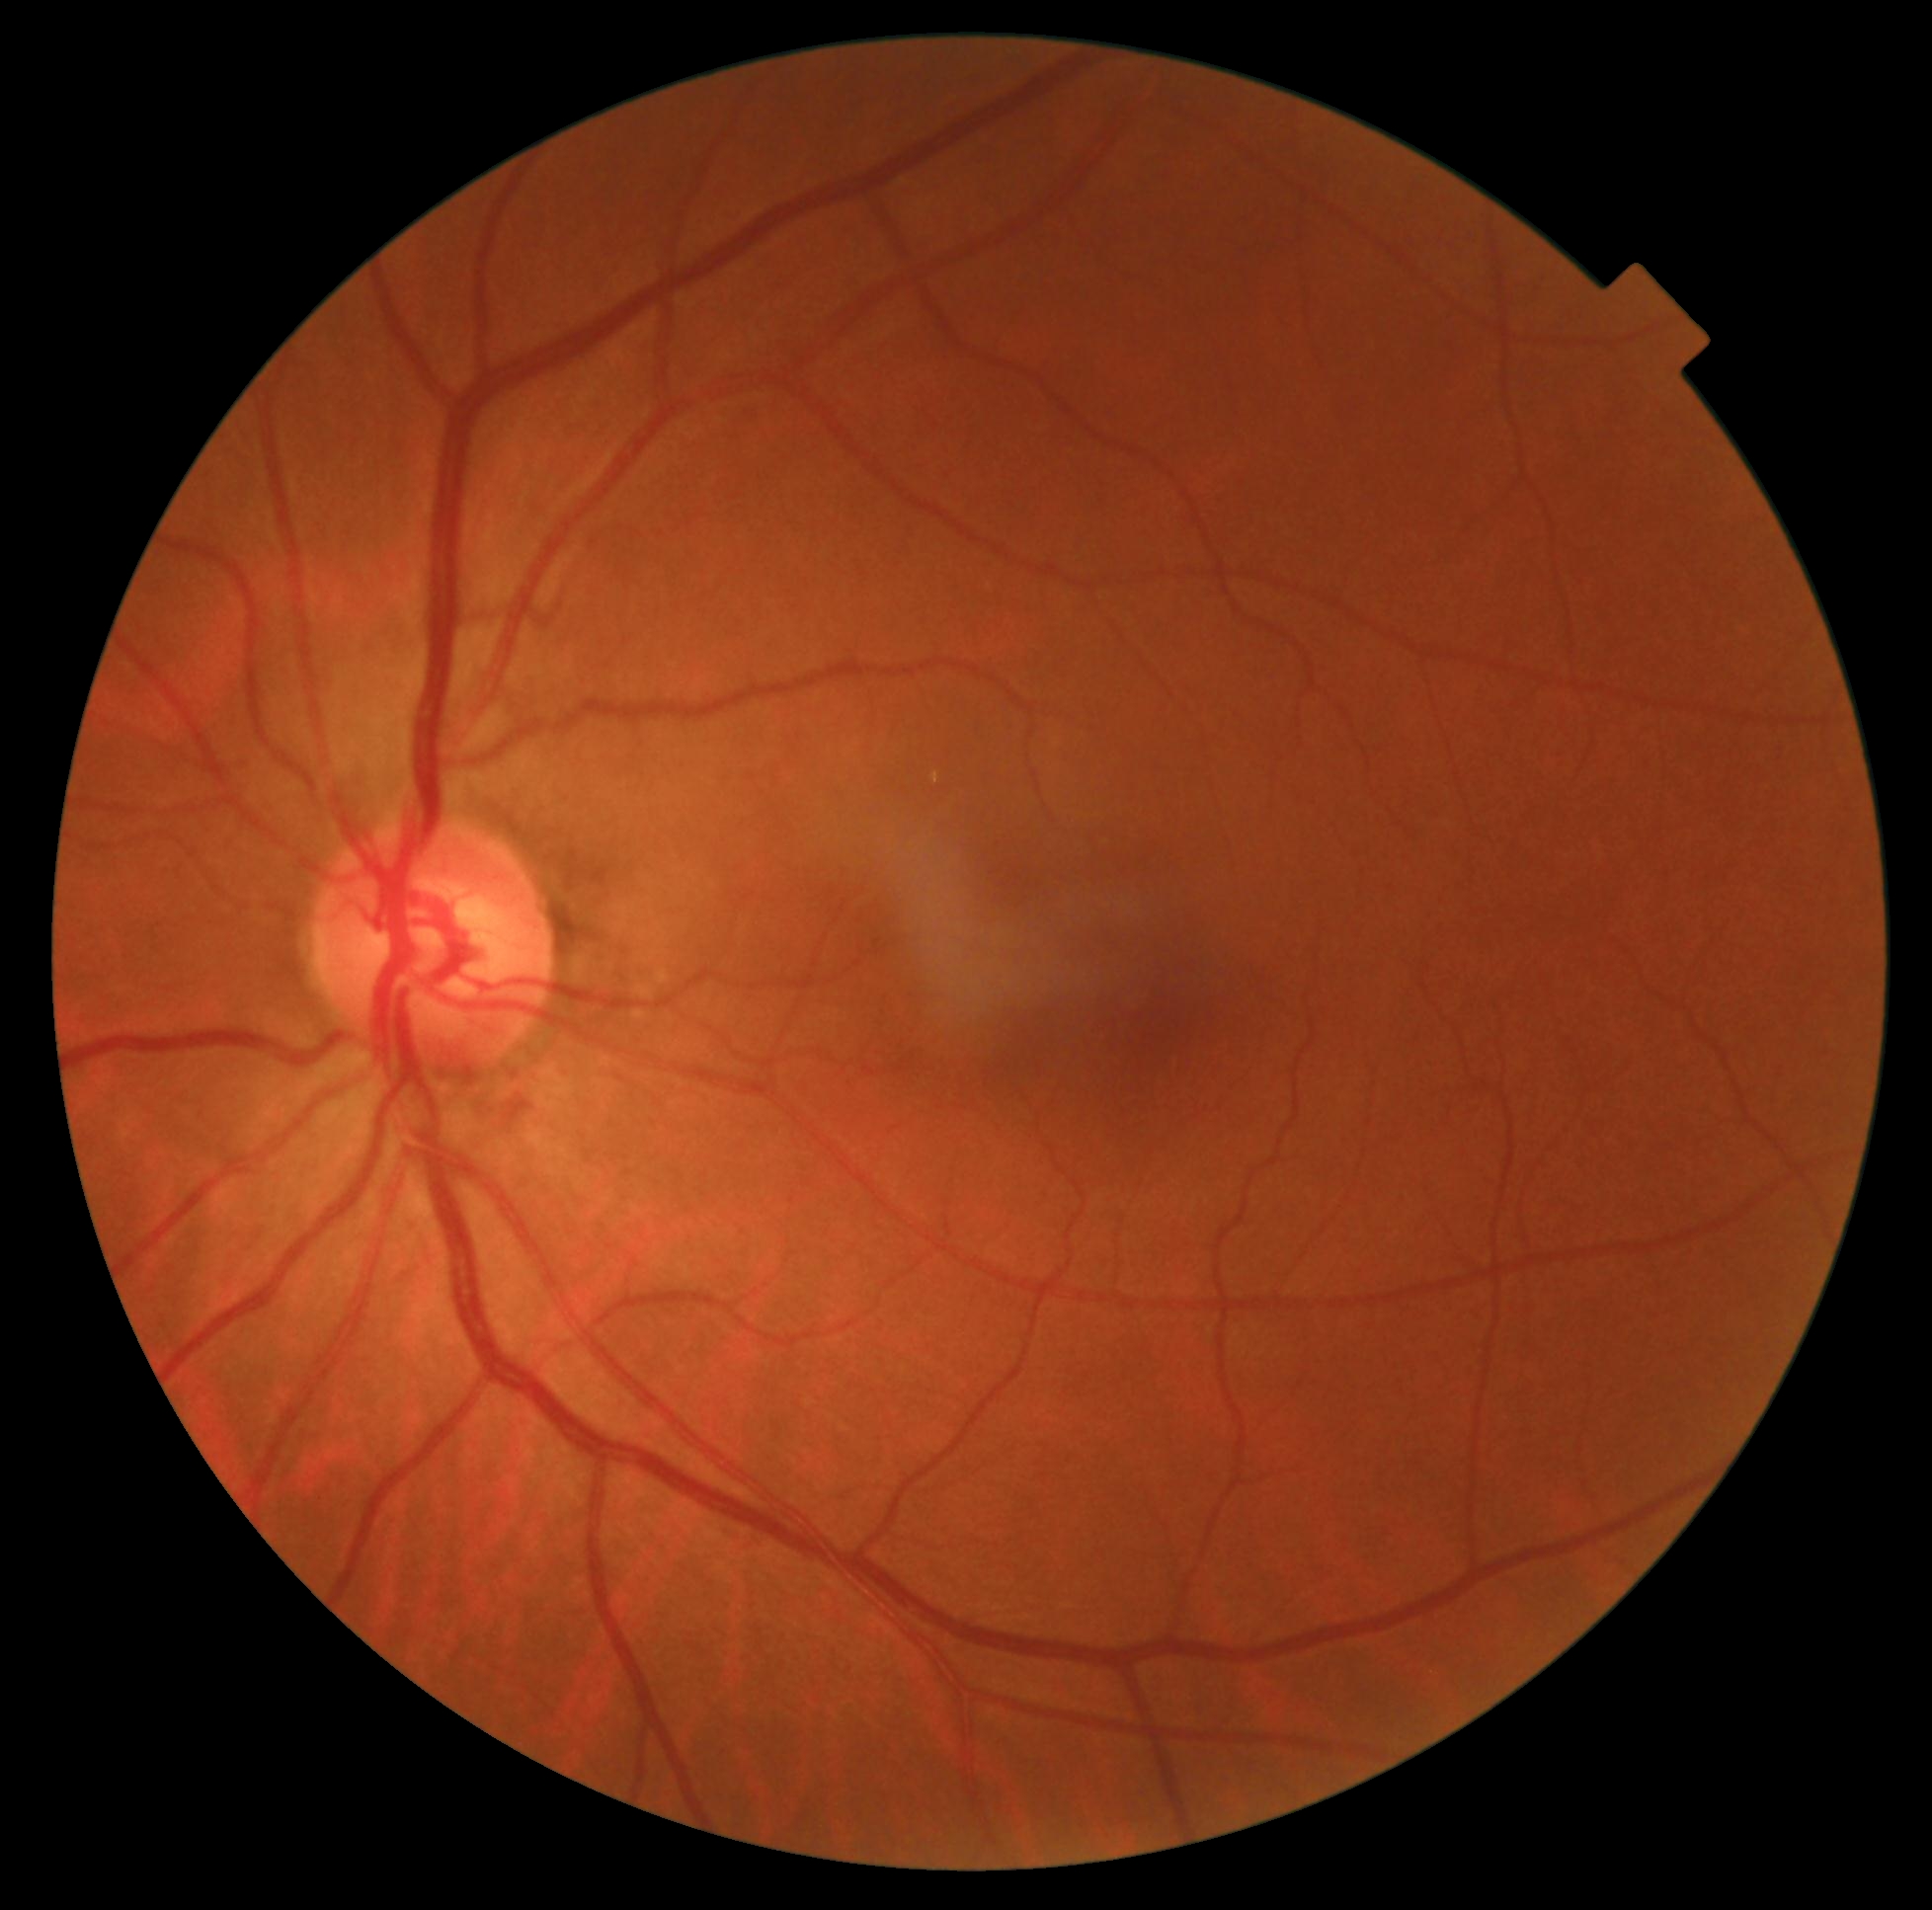

dr_grade: 0/4 — no visible signs of diabetic retinopathy
dr_impression: no apparent DR